Pediatric wide-field fundus photograph: 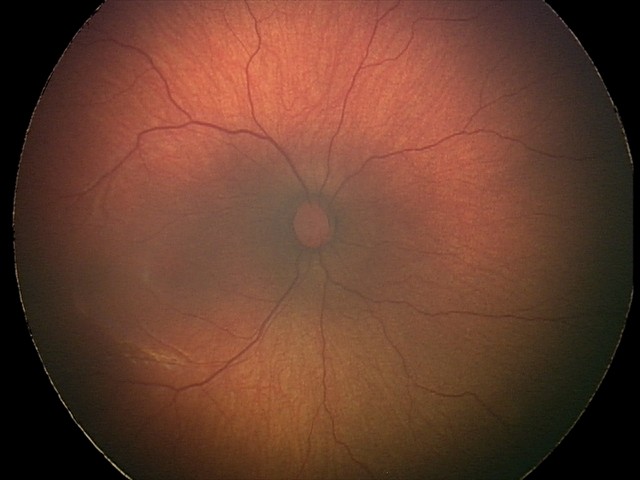

No plus disease.
Series diagnosed as status post retinopathy of prematurity (ROP).